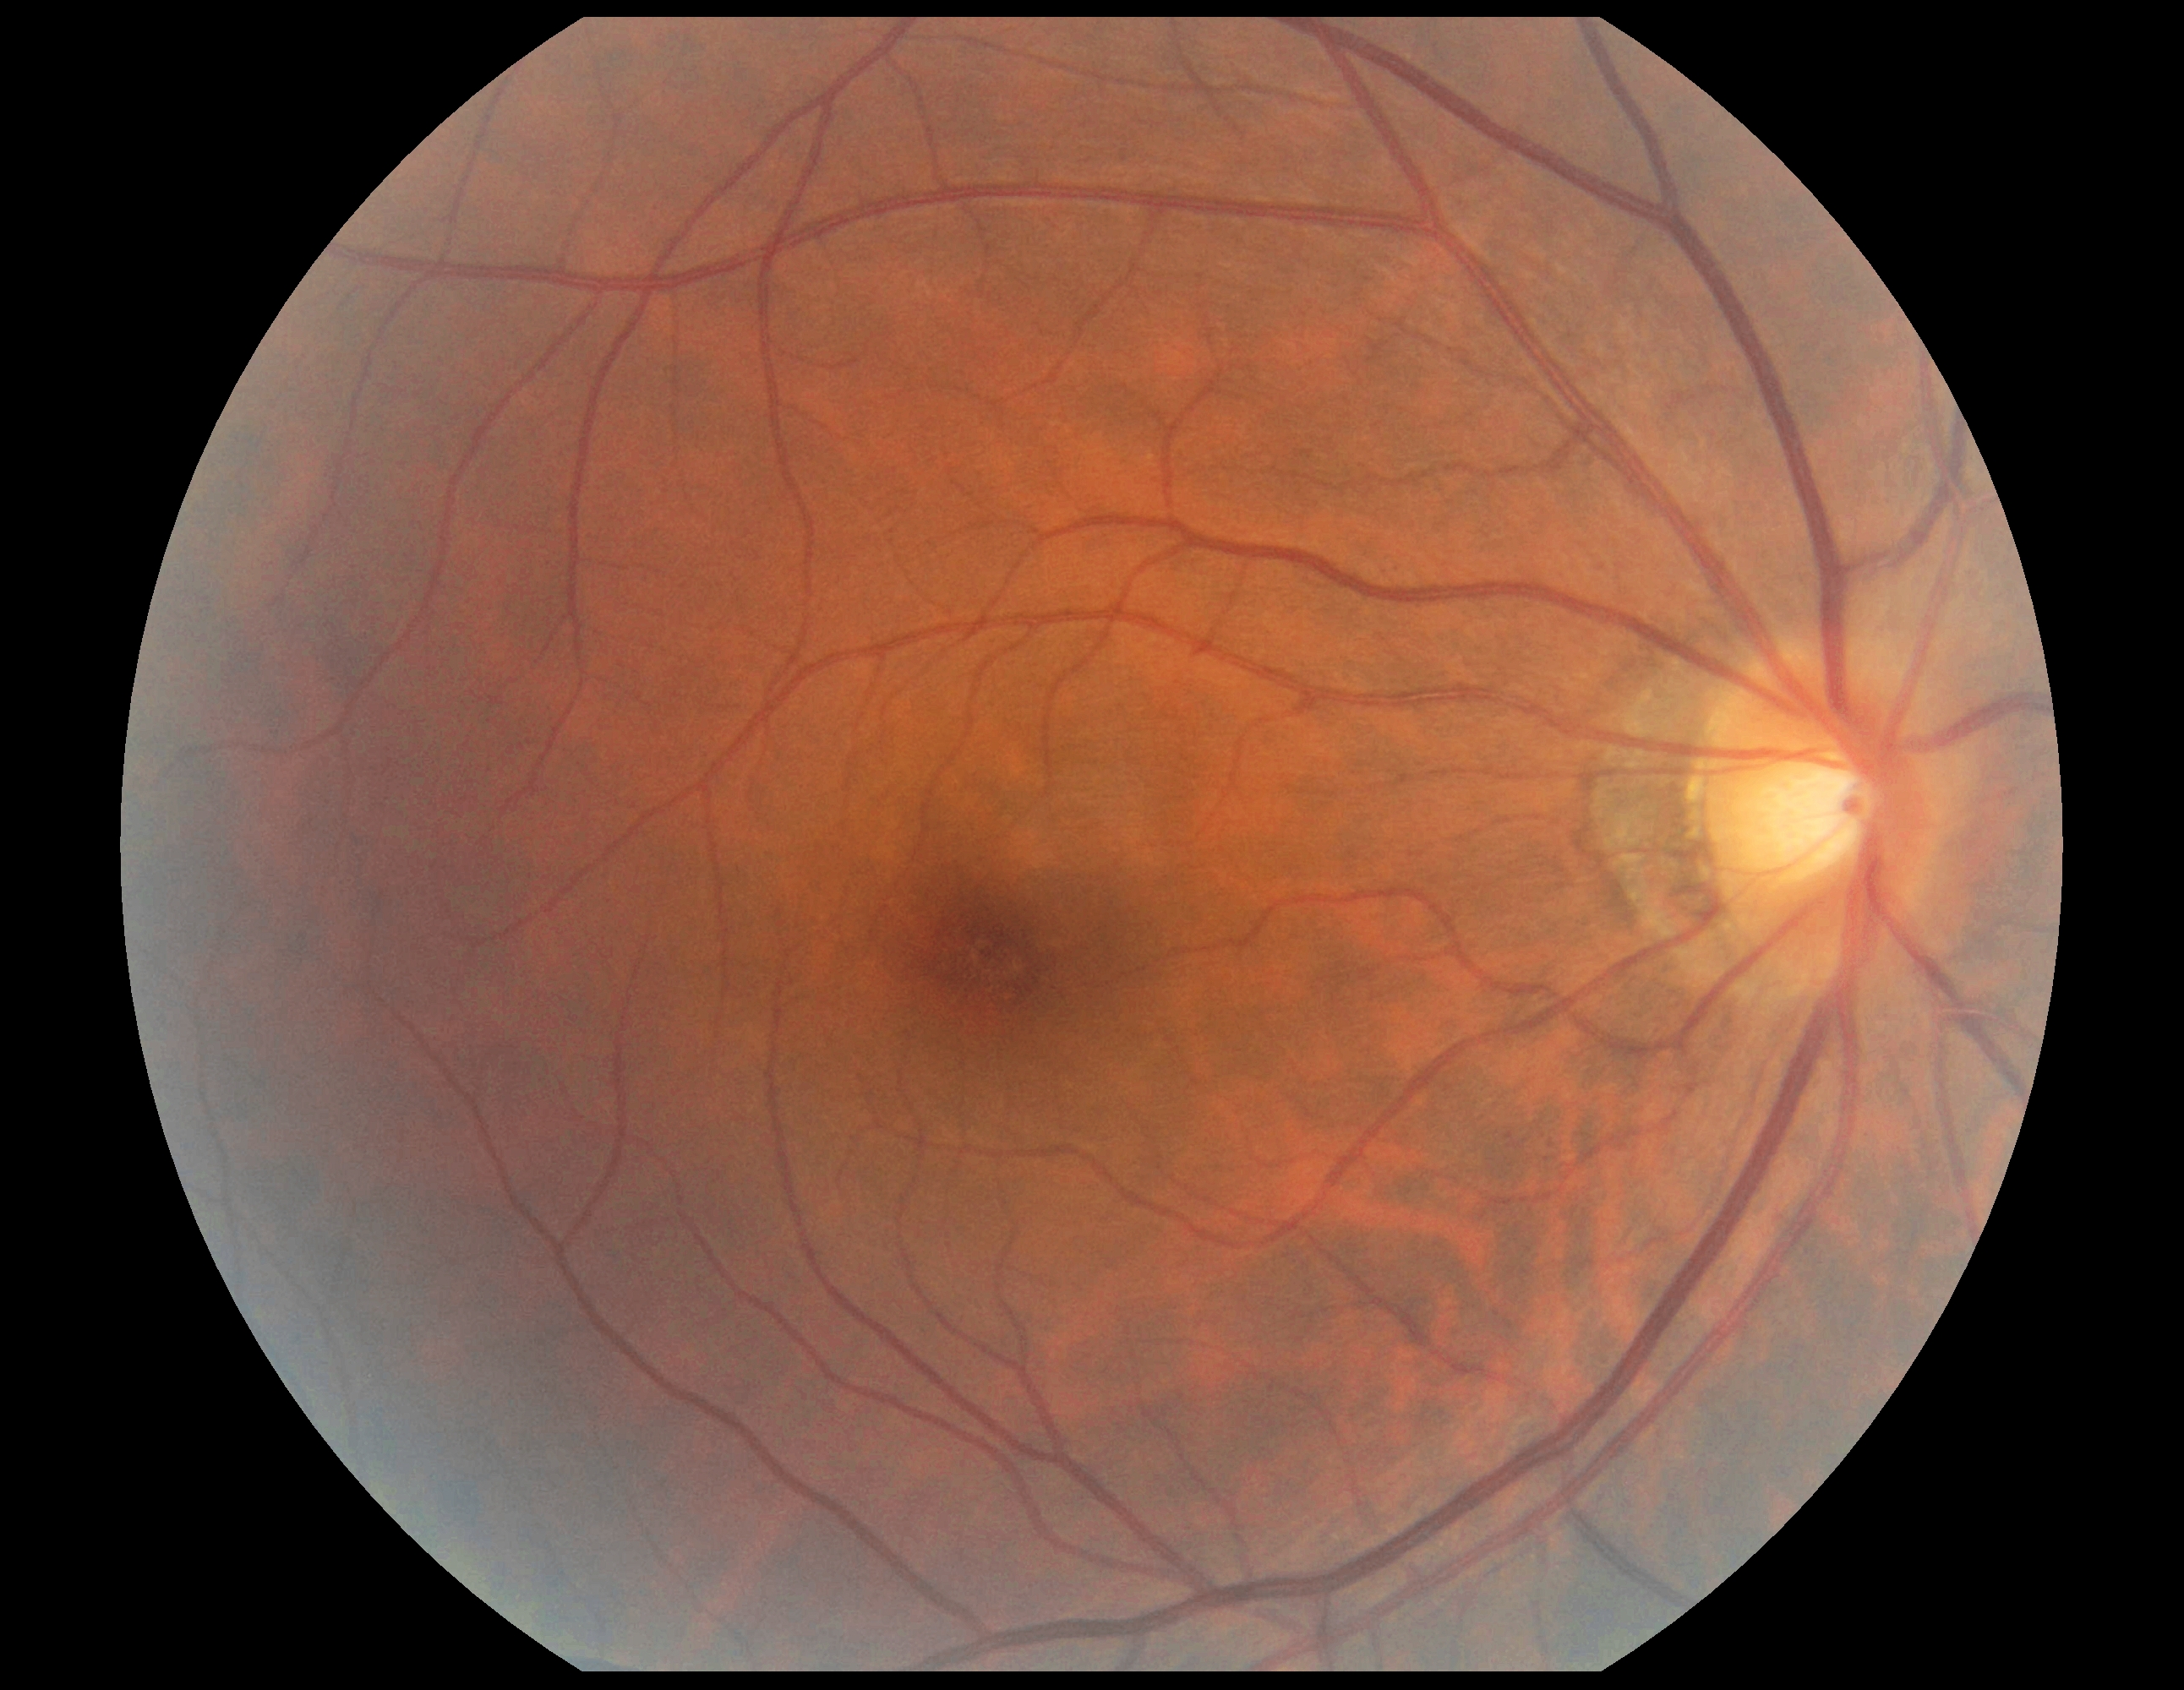

Diabetic retinopathy (DR) is no apparent diabetic retinopathy (grade 0).